1240 by 1240 pixels · wide-field fundus photograph of an infant:
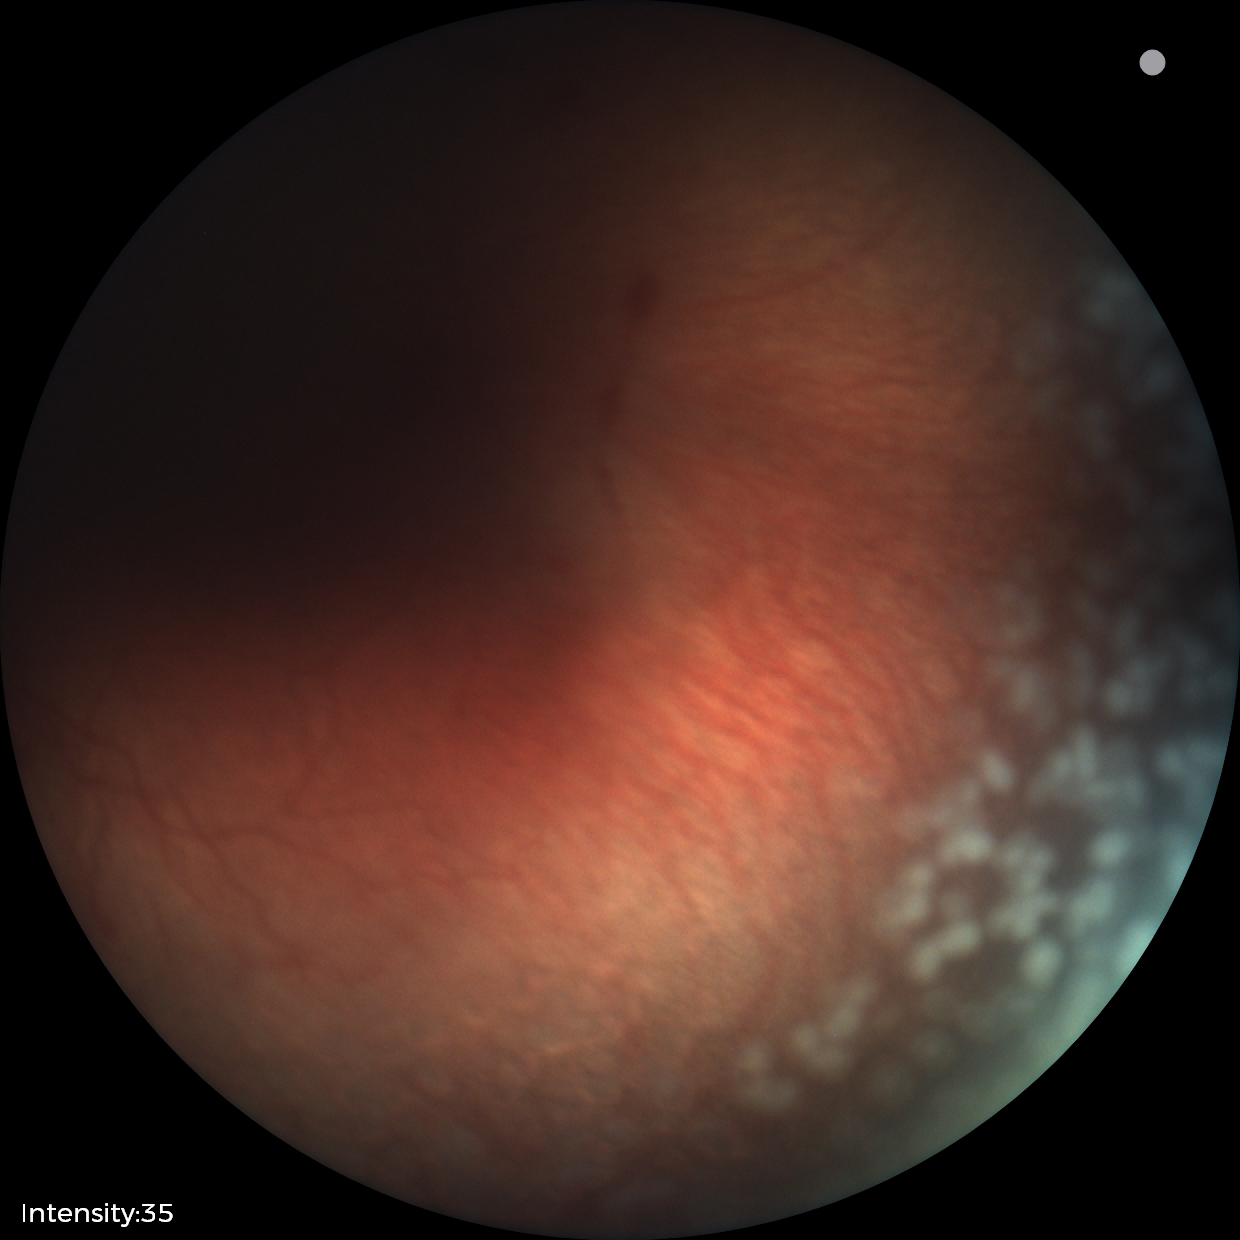
Screening: retinopathy of prematurity stage 2; plus disease.